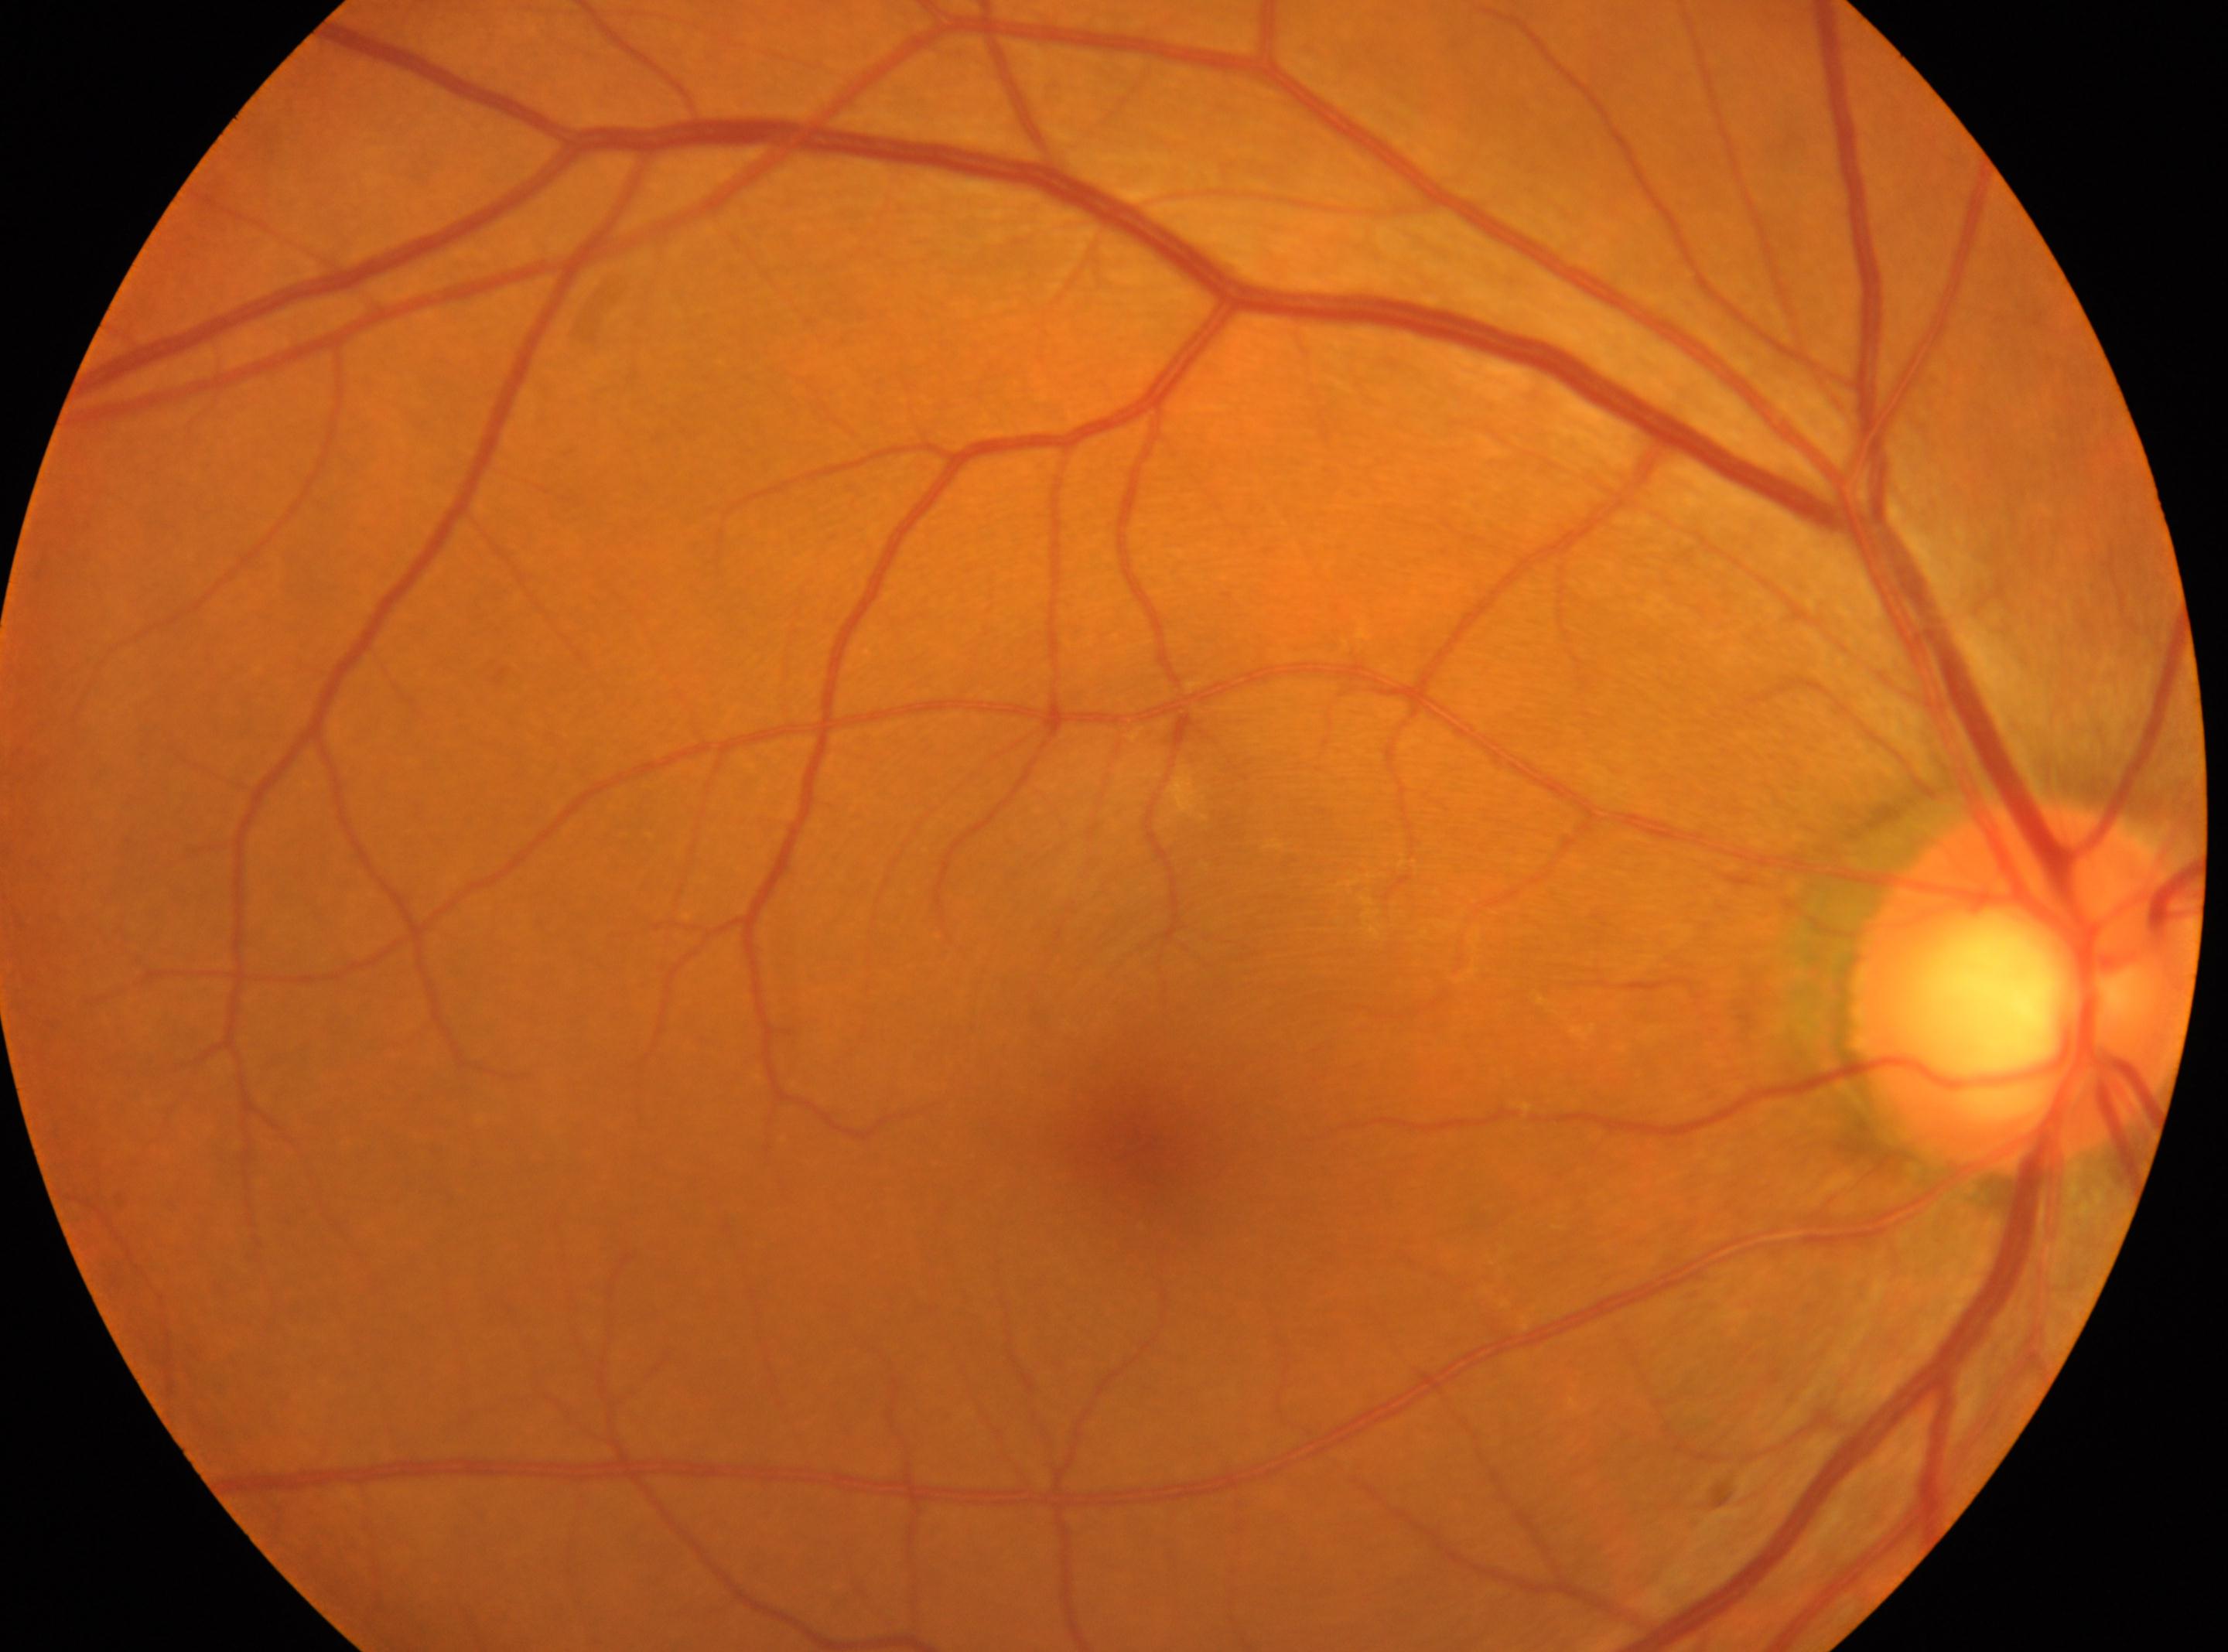
• DR stage — no apparent diabetic retinopathy (grade 0)
• laterality — right eye
• foveal center — x=1125, y=1142
• disc center — x=2024, y=988